1932x1916px.
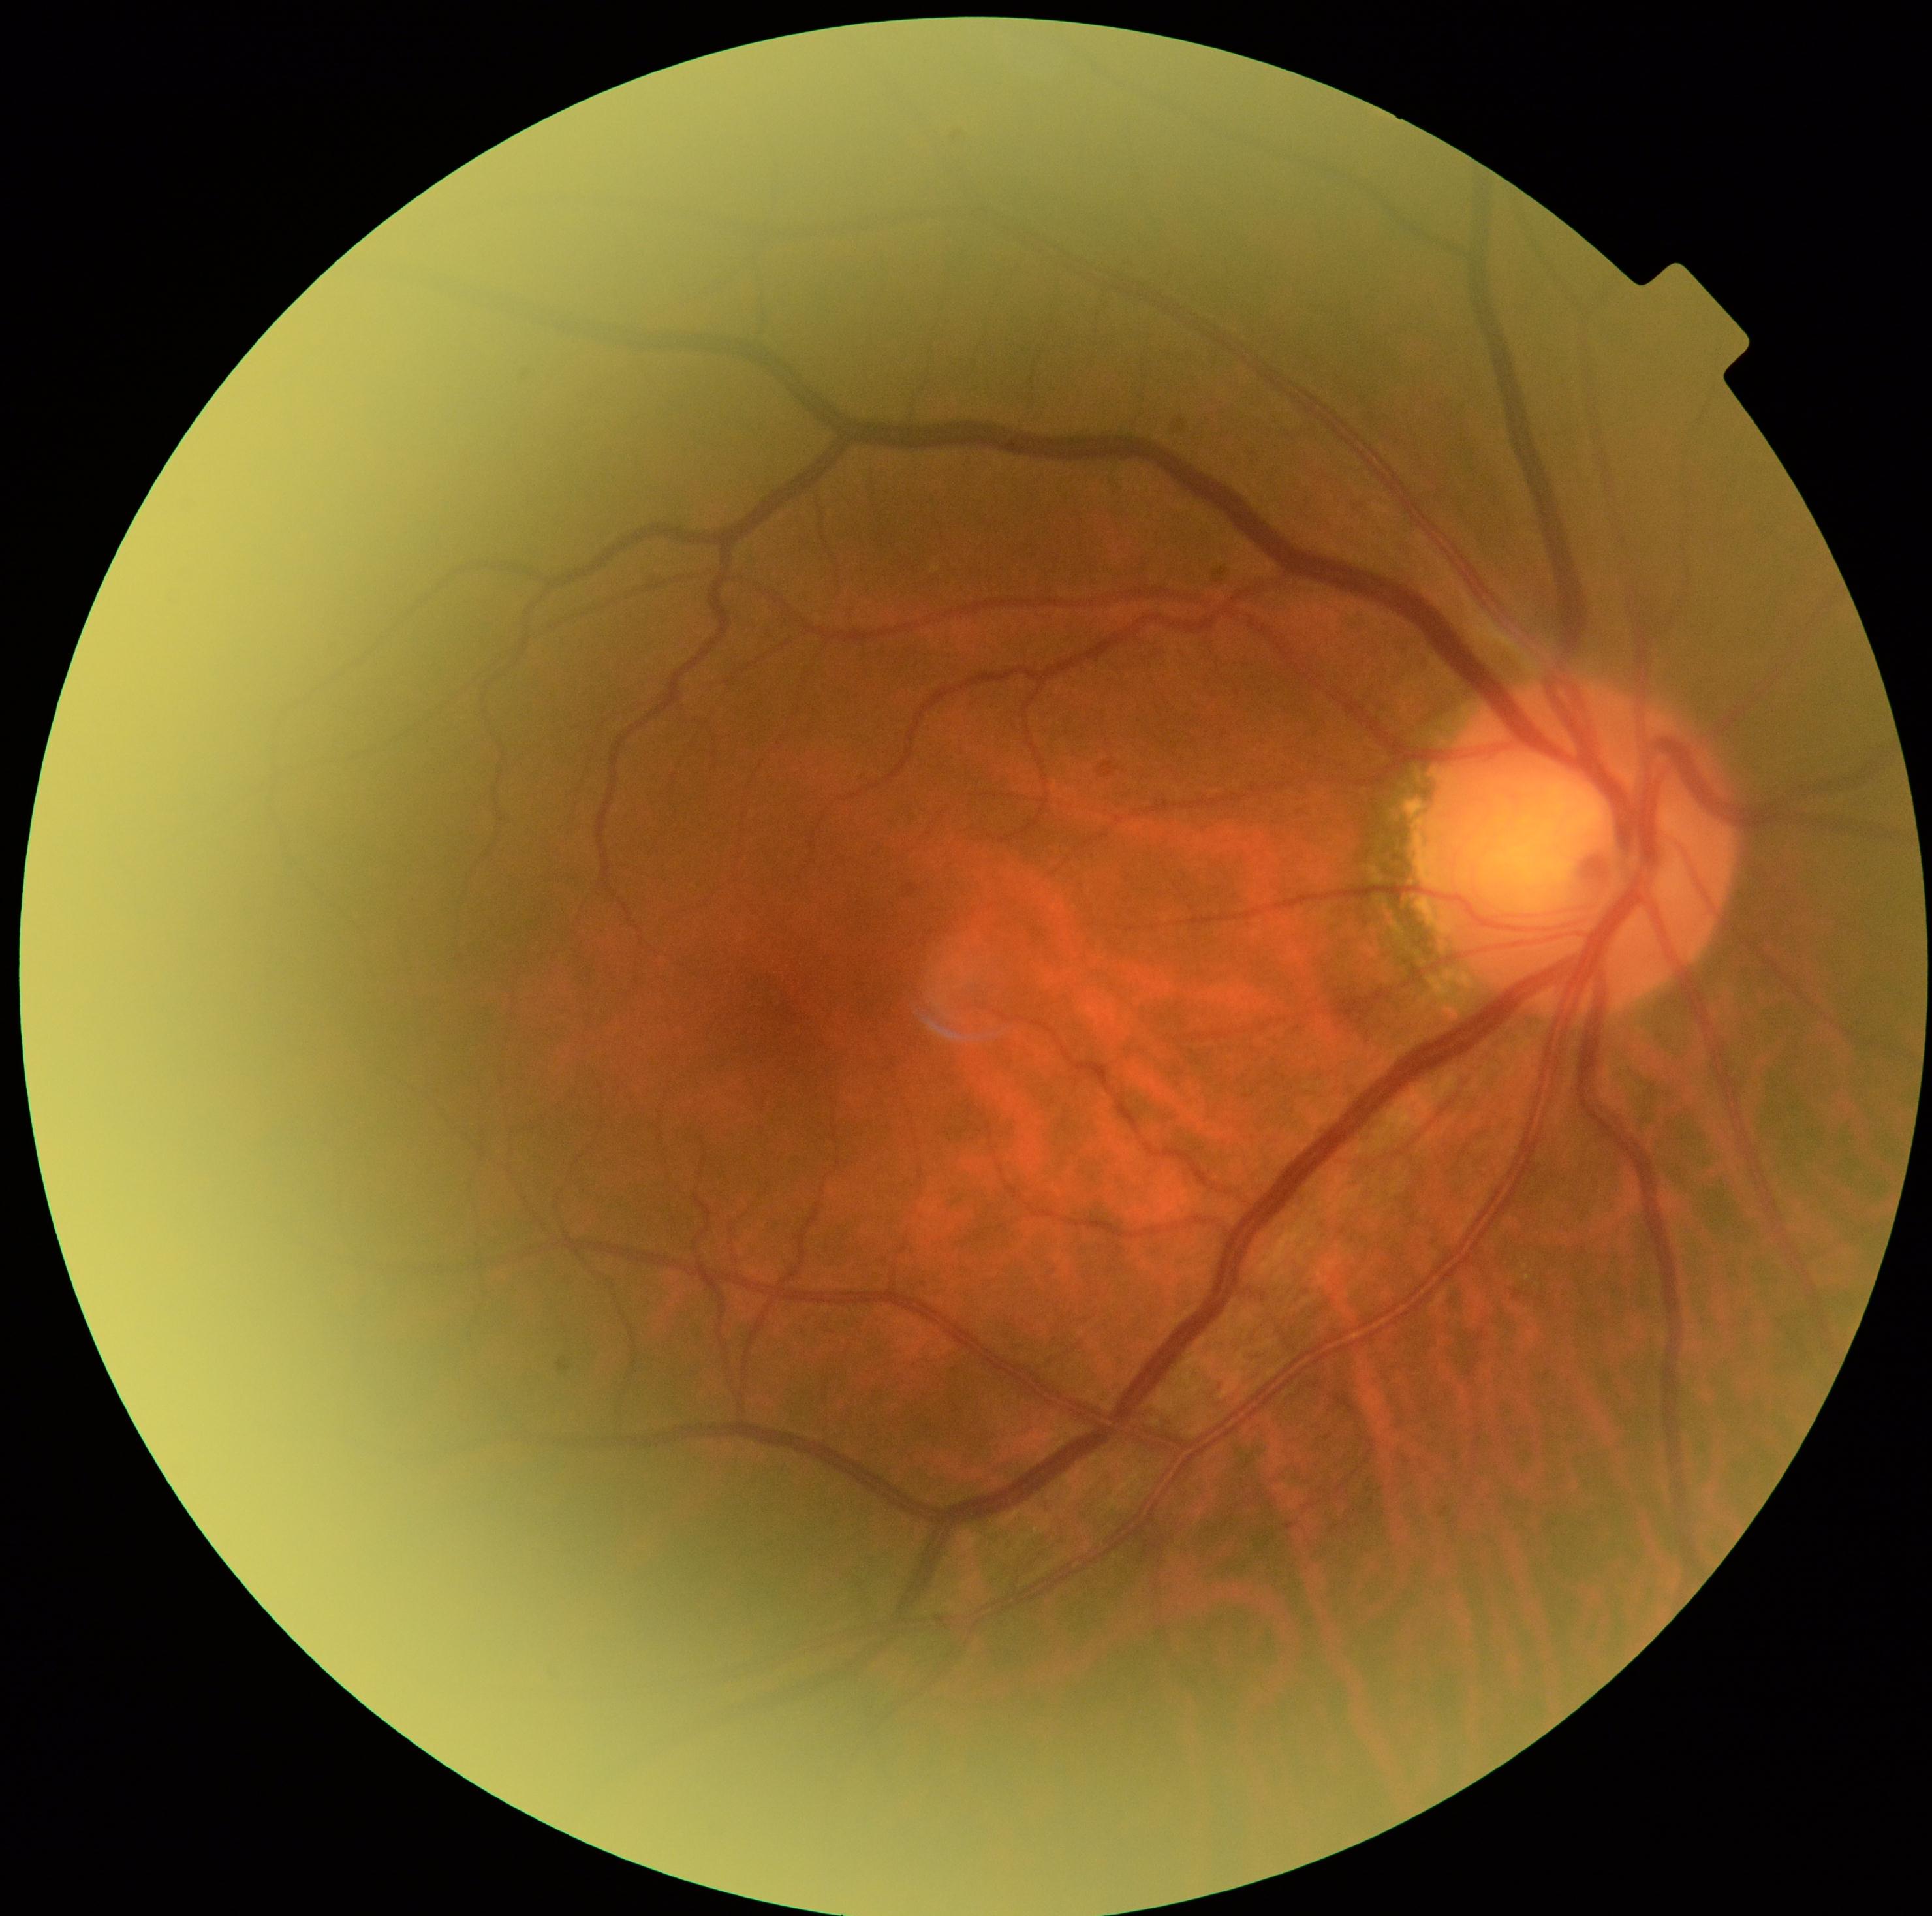

DR@no apparent diabetic retinopathy (grade 0).